848x848 · 45 degree fundus photograph:
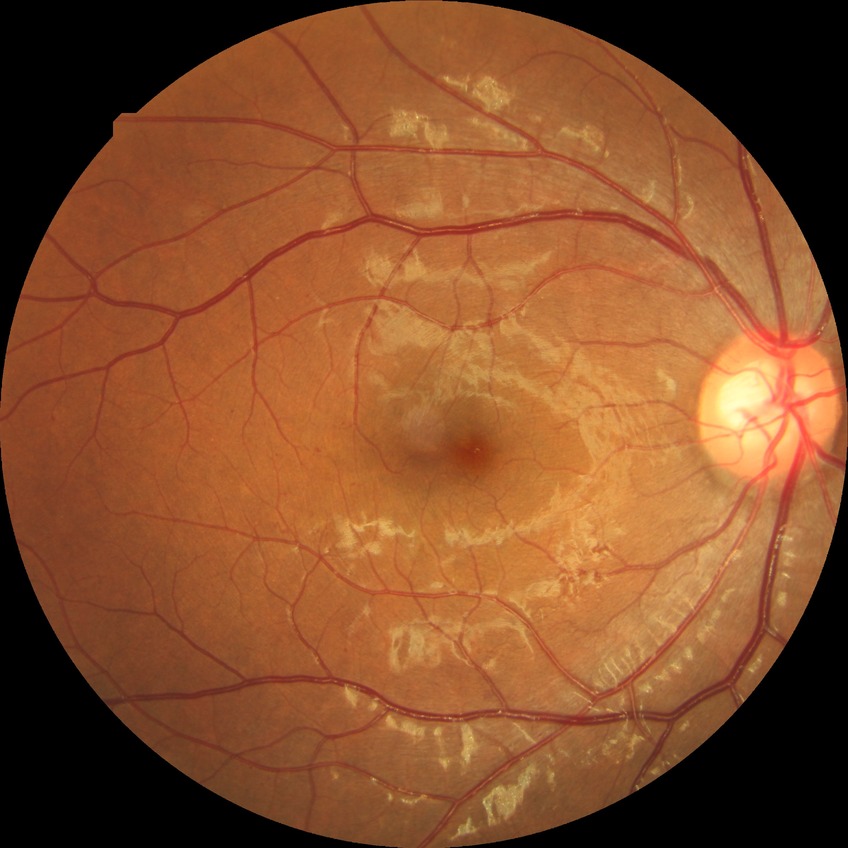
diabetic retinopathy stage = simple diabetic retinopathy.